DR severity per modified Davis staging: 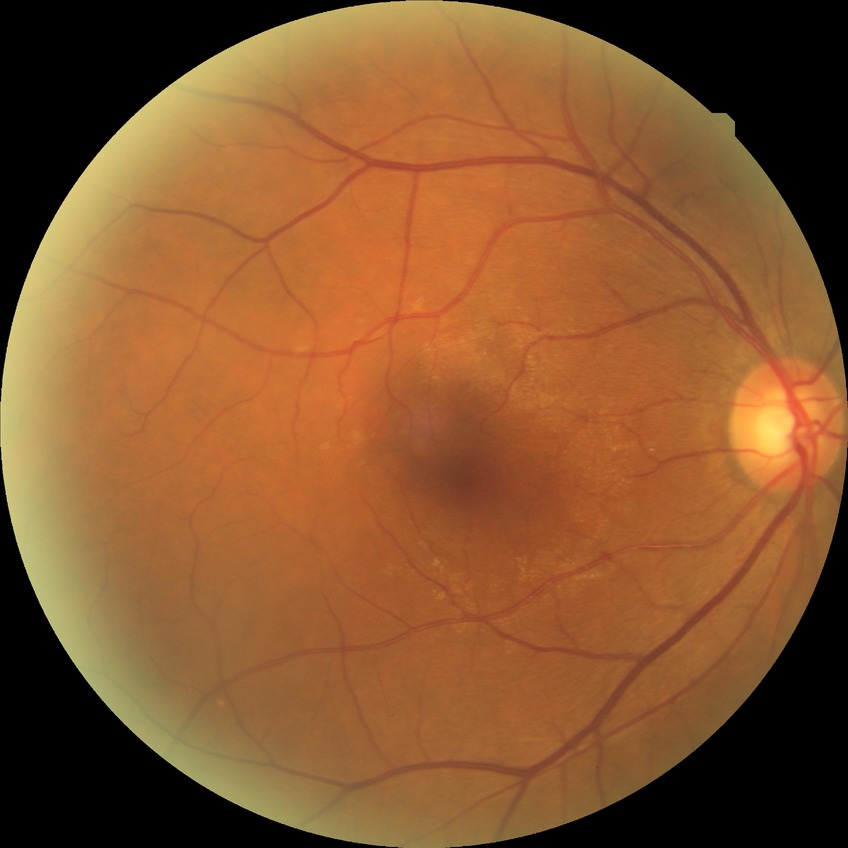

No DR findings. Davis stage is NDR.